FOV: 45 degrees
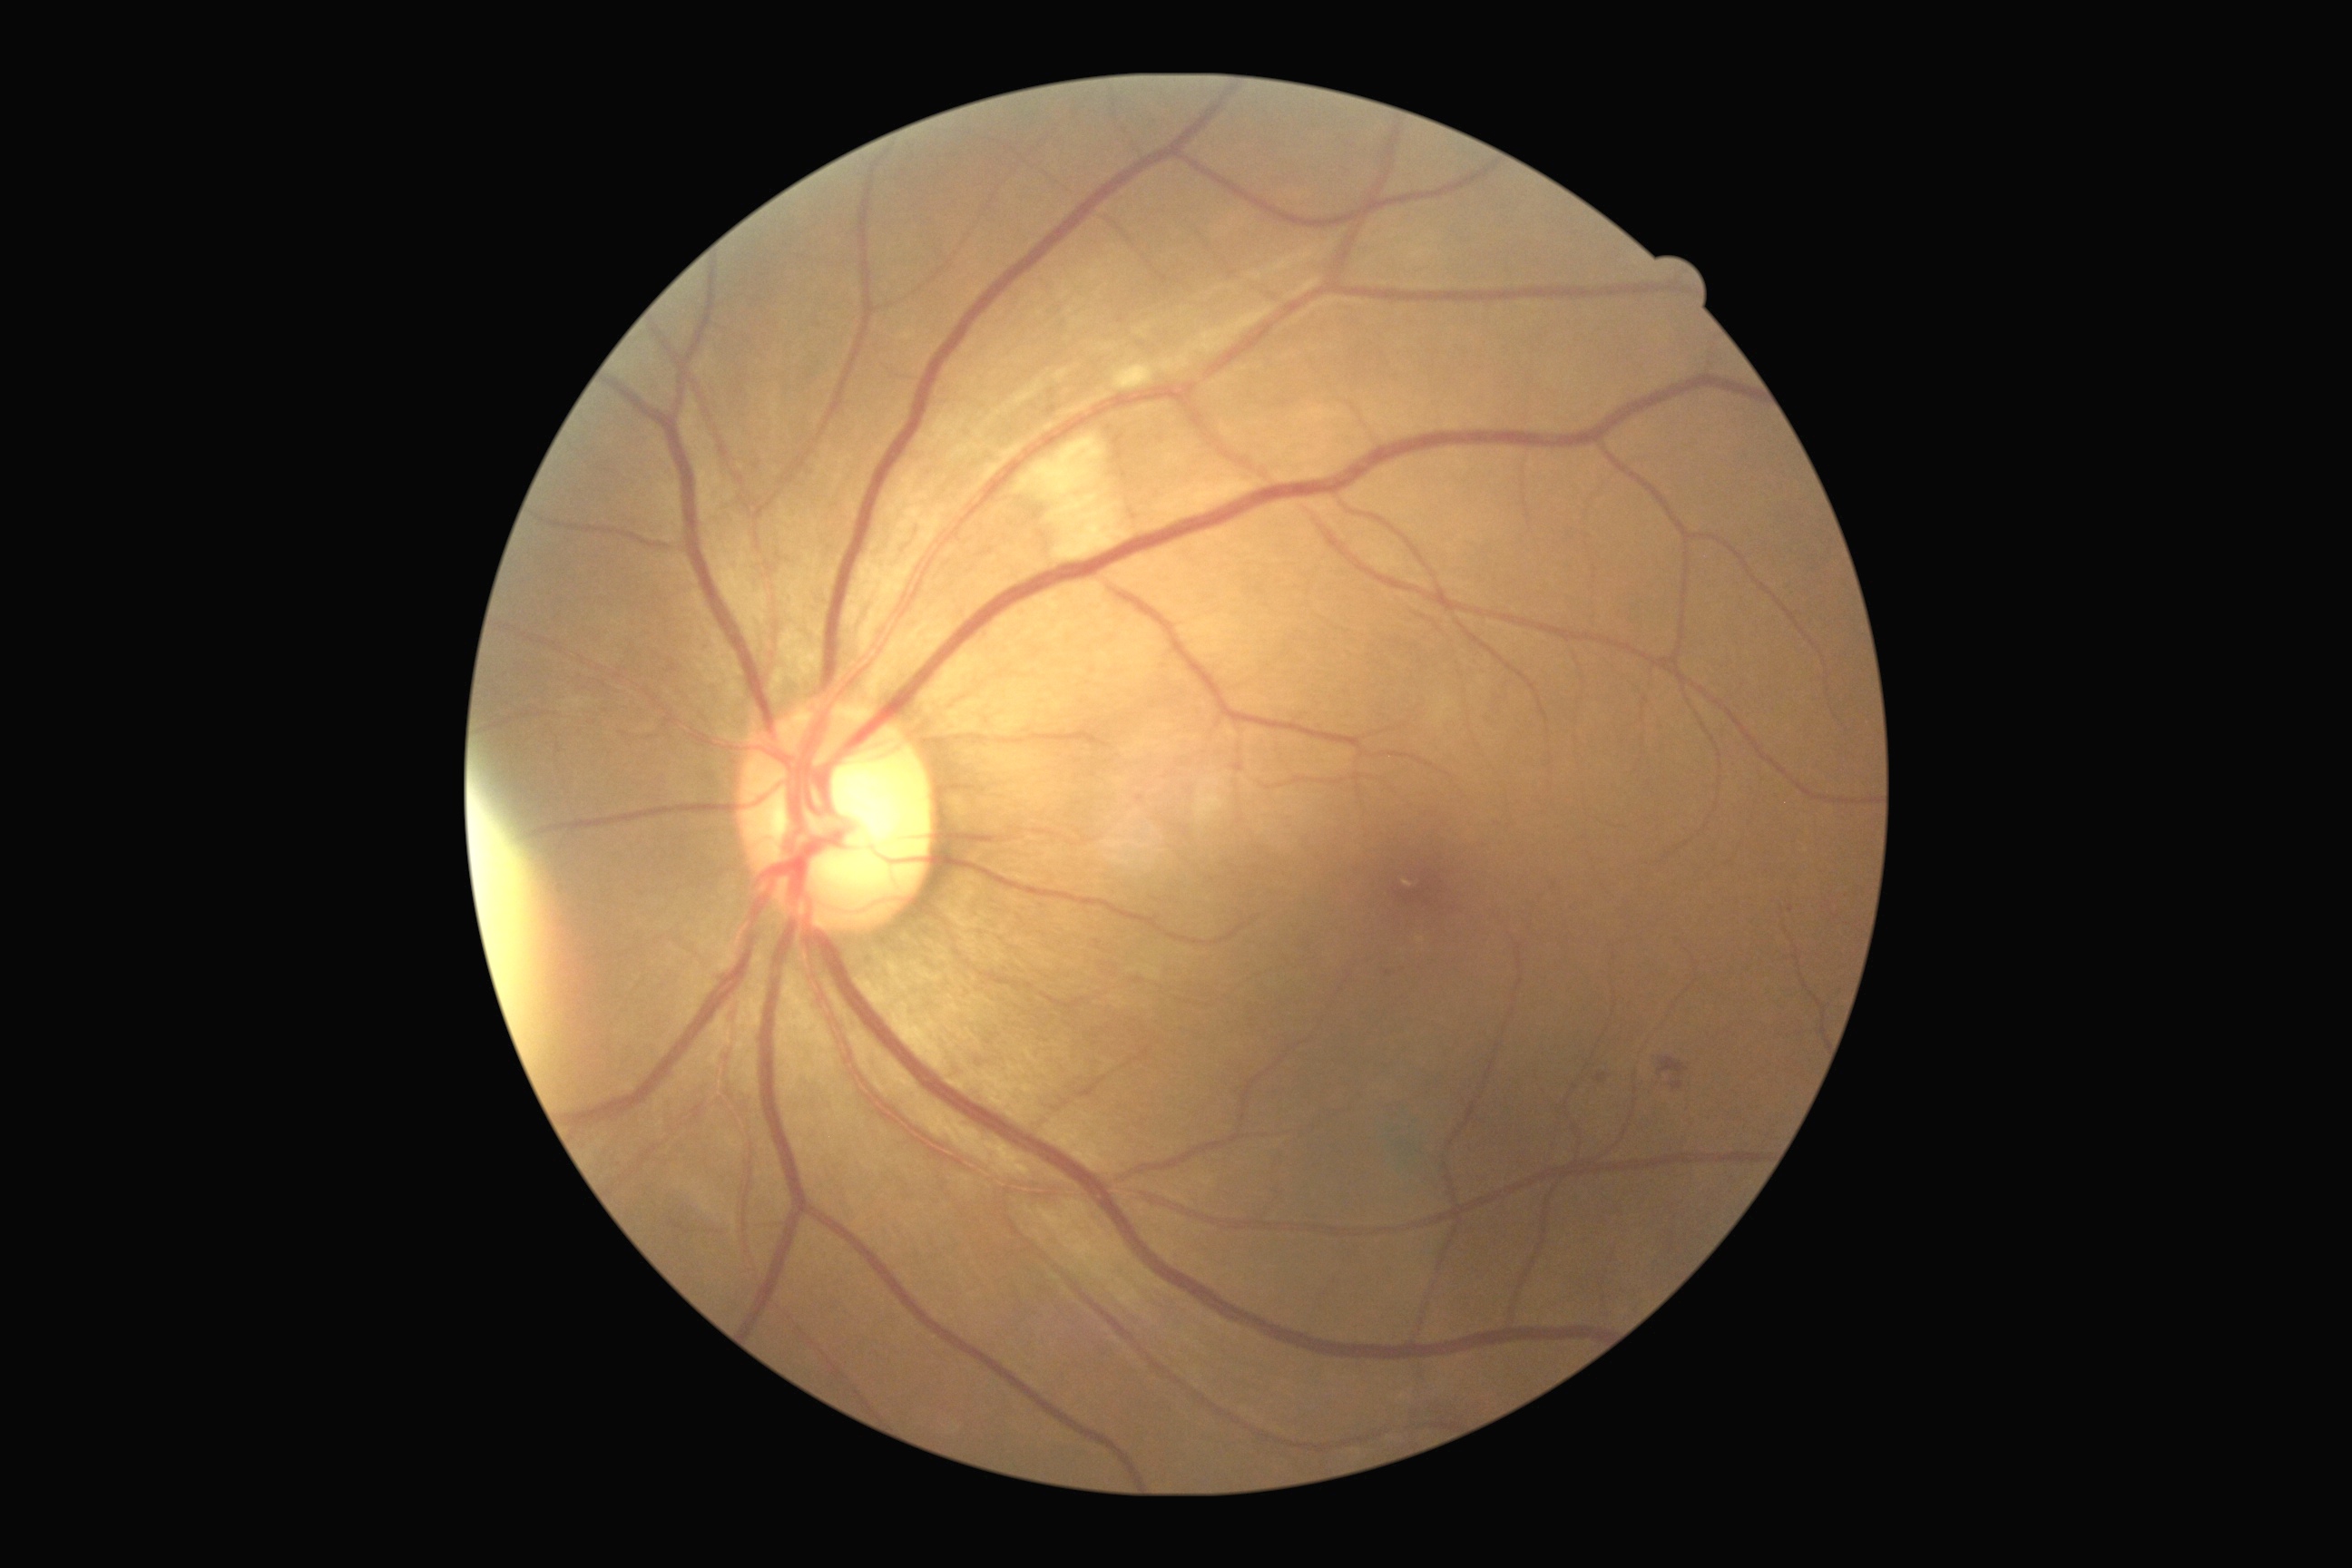
Diabetic retinopathy severity: moderate NPDR (grade 2).